Diabetic retinopathy graded by the modified Davis classification; posterior pole photograph
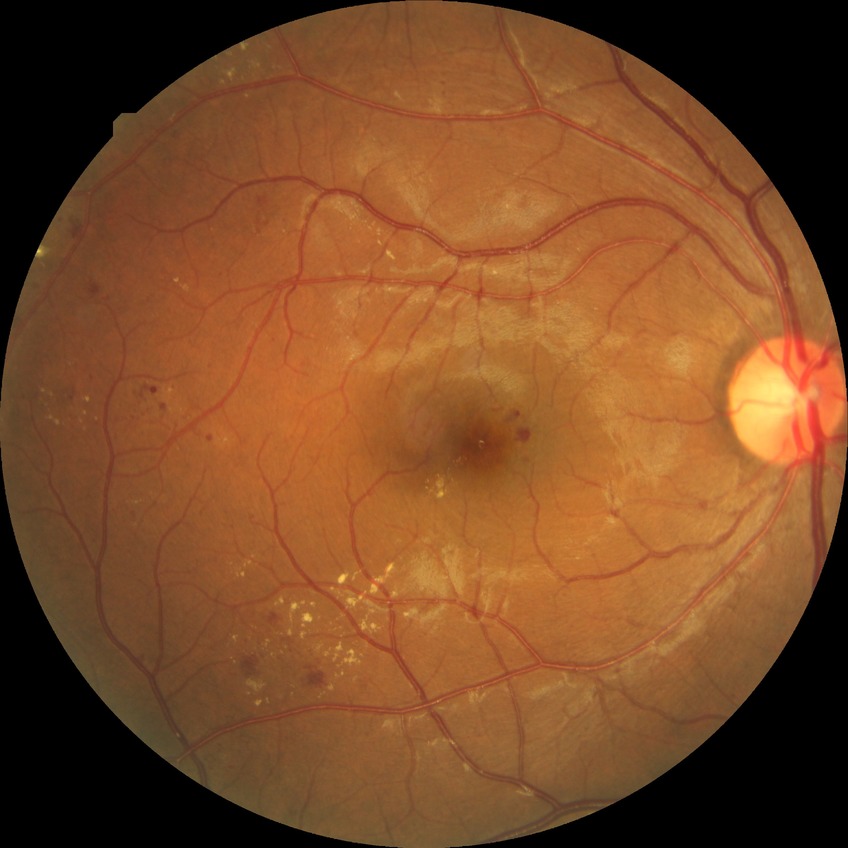

Diabetic retinopathy (DR) is SDR (simple diabetic retinopathy).